Wide-field fundus photograph of an infant; captured with the Clarity RetCam 3 (130° field of view); 640 x 480 pixels:
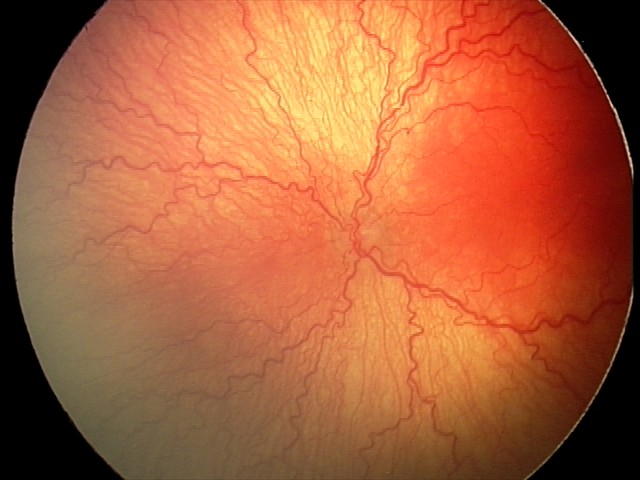

Q: What was the screening finding?
A: aggressive ROP (A-ROP)
Q: What is the plus-form classification?
A: plus disease